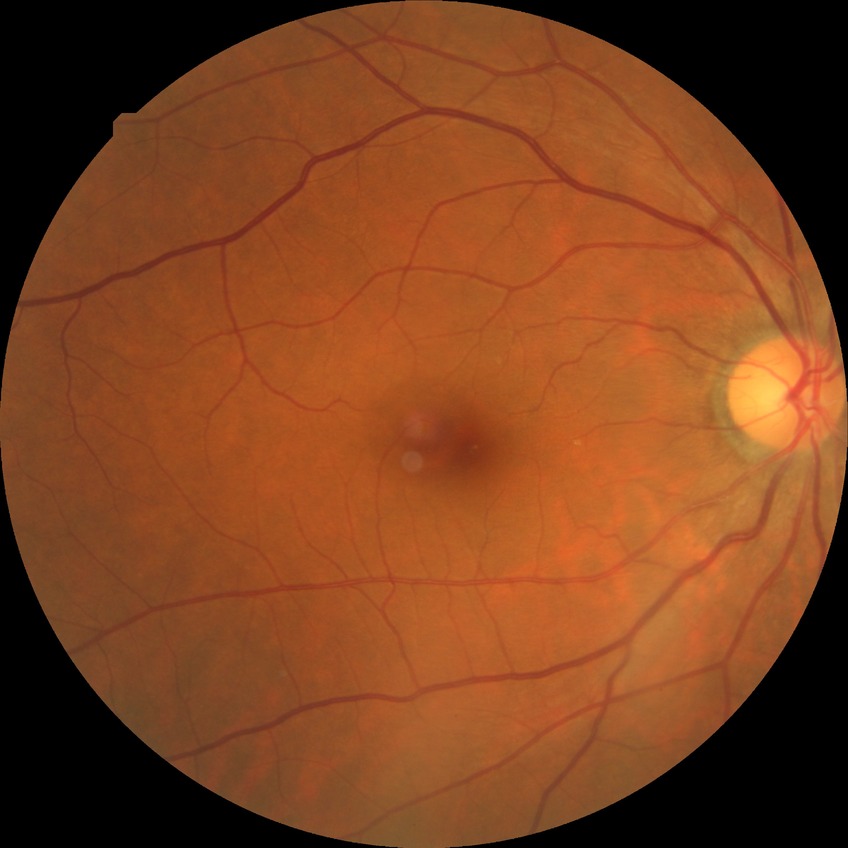
davis_grade: simple diabetic retinopathy